Nonmydriatic fundus photograph, acquired with a NIDEK AFC-230:
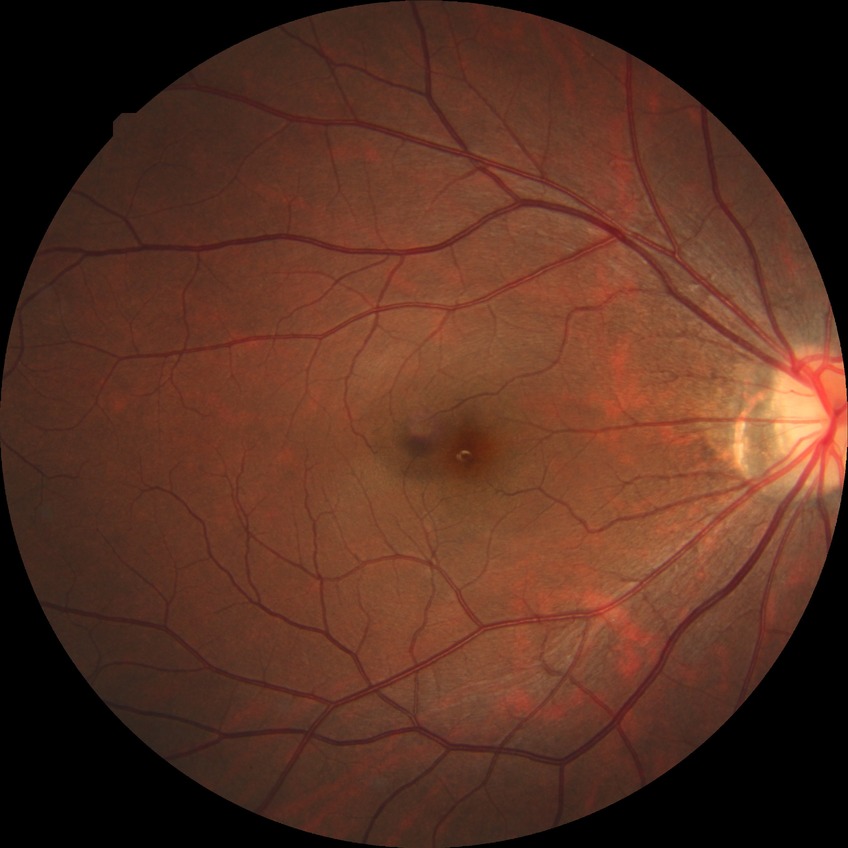
Diabetic retinopathy (DR): no diabetic retinopathy (NDR).